1440x1080. Pediatric retinal photograph (wide-field) — 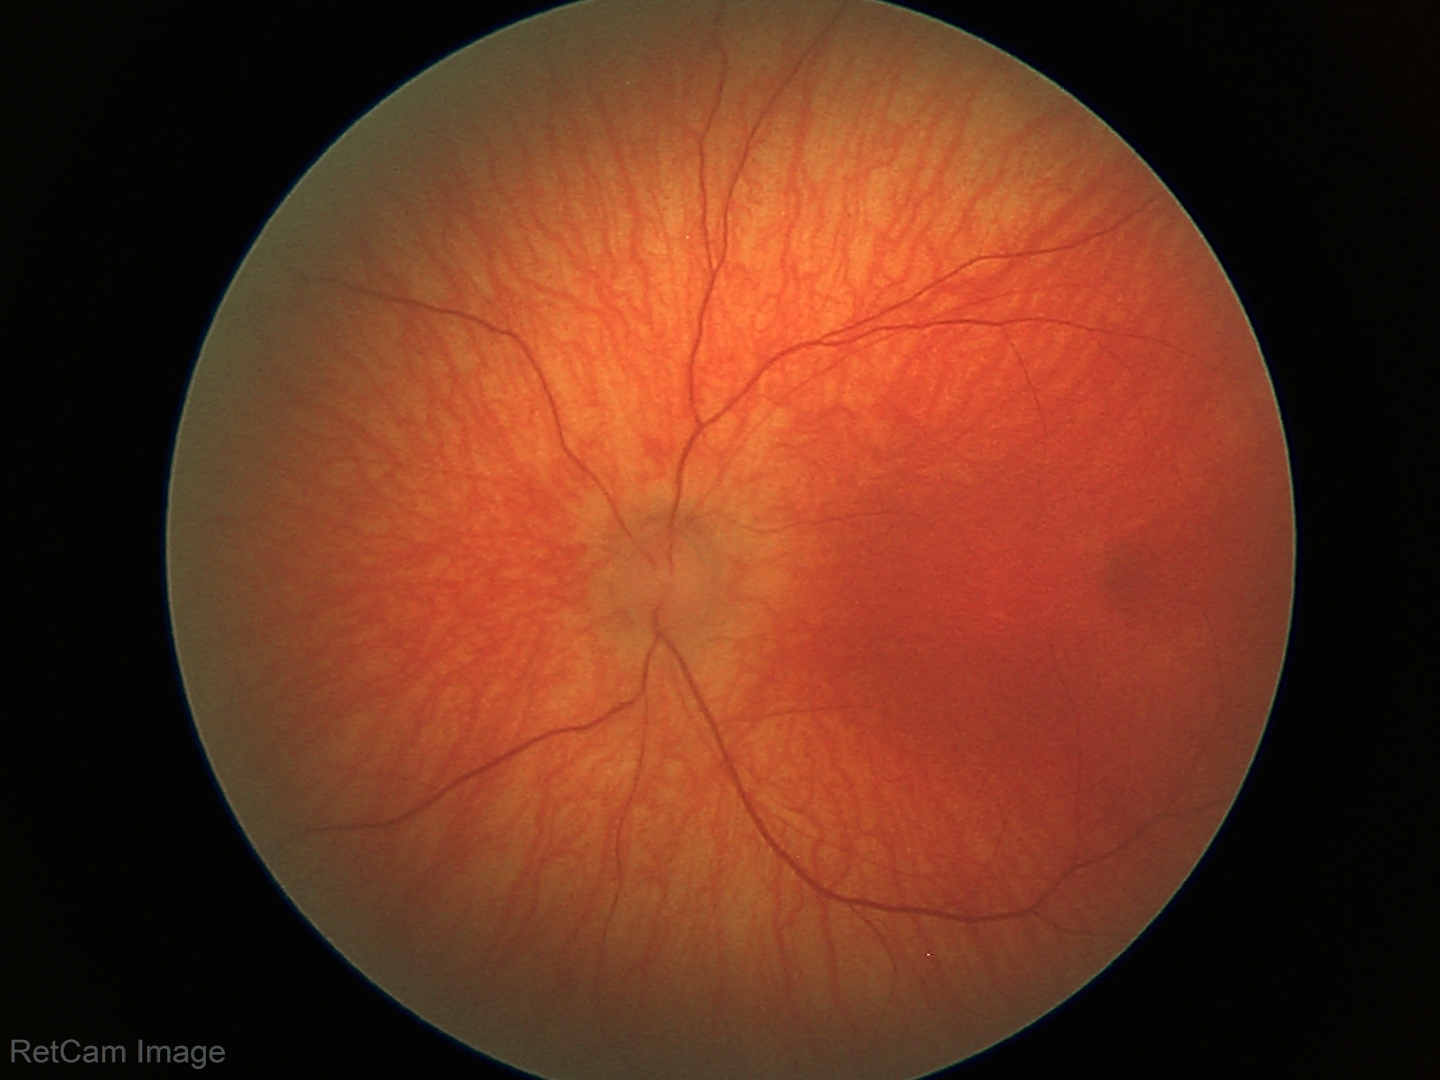 Screening examination diagnosed as physiological.